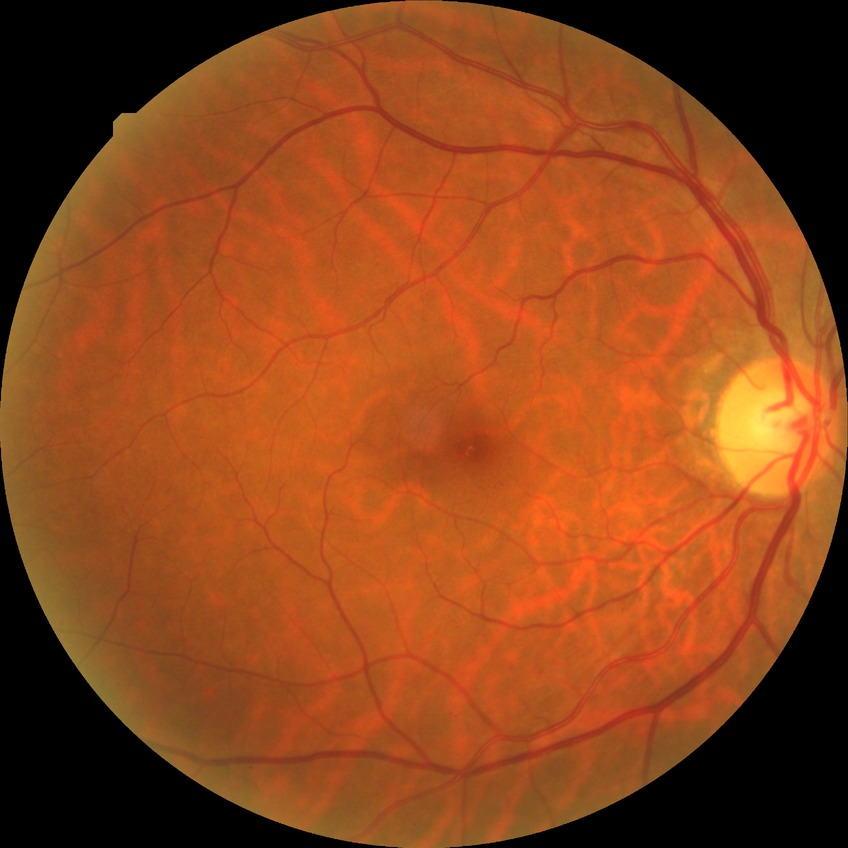 Diabetic retinopathy (DR) is no diabetic retinopathy (NDR).